2346 x 1568 pixels · 45° field of view: 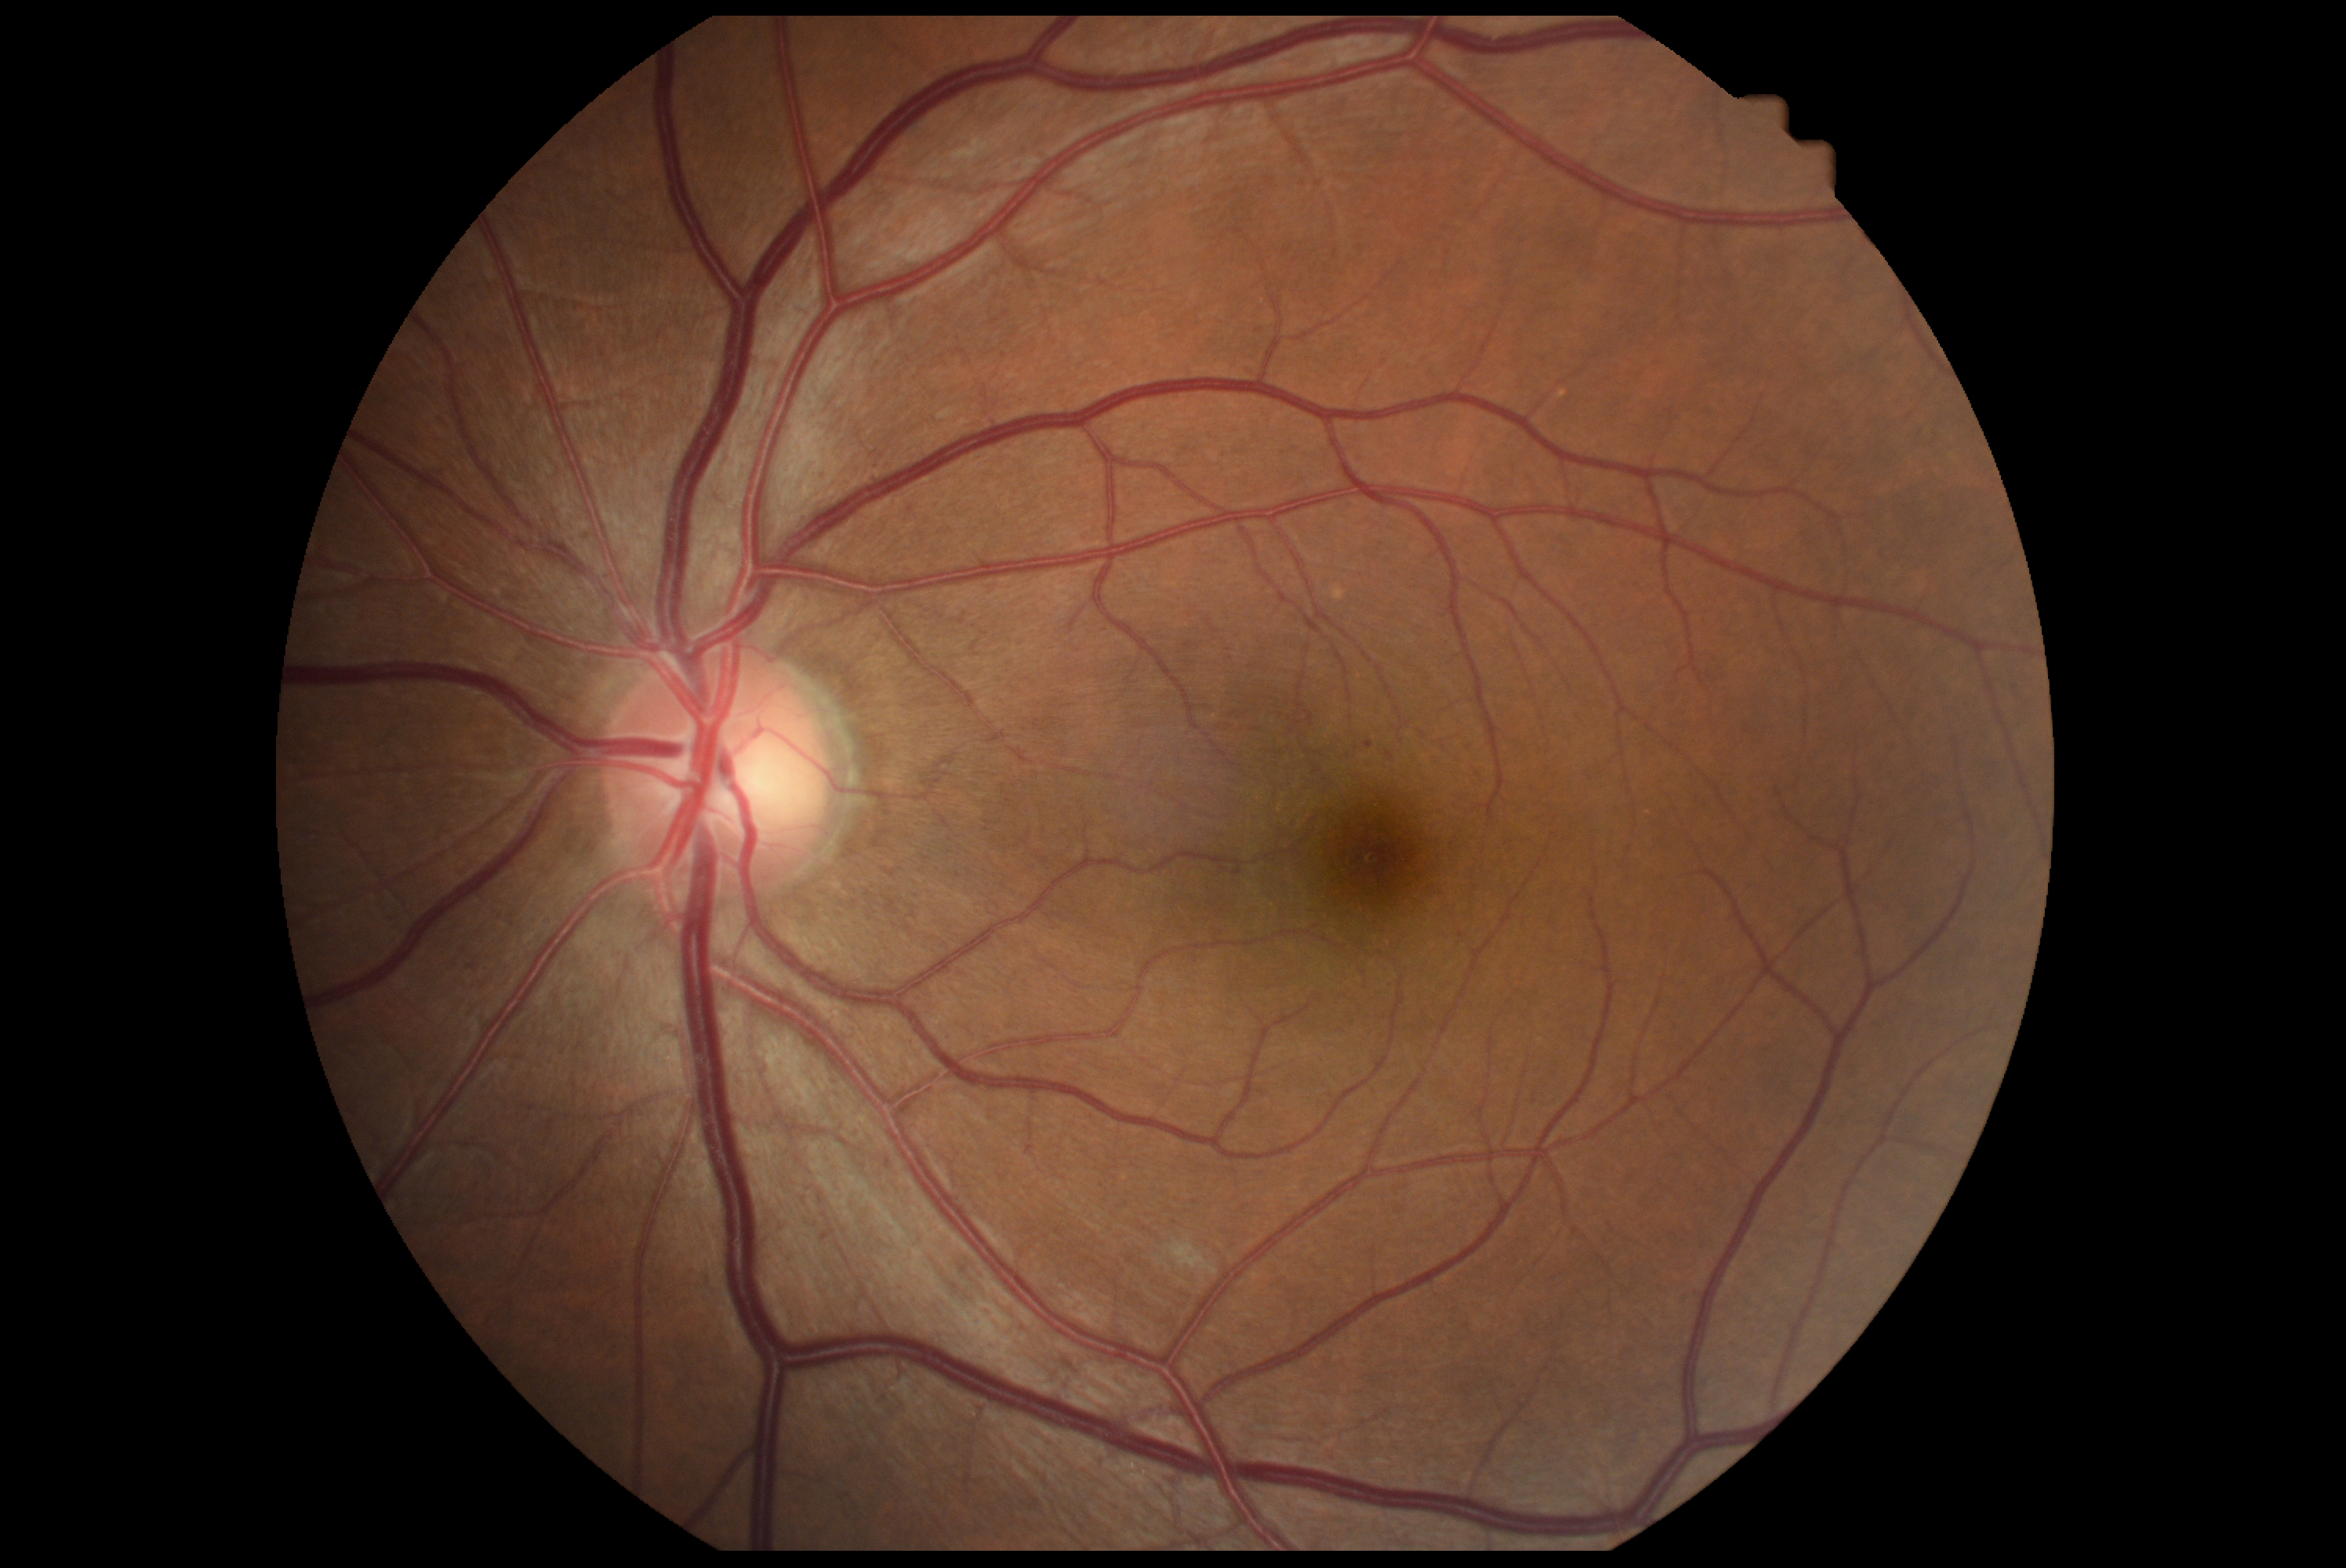 DR stage is grade 2 (moderate NPDR).